Image size 2102x1736: 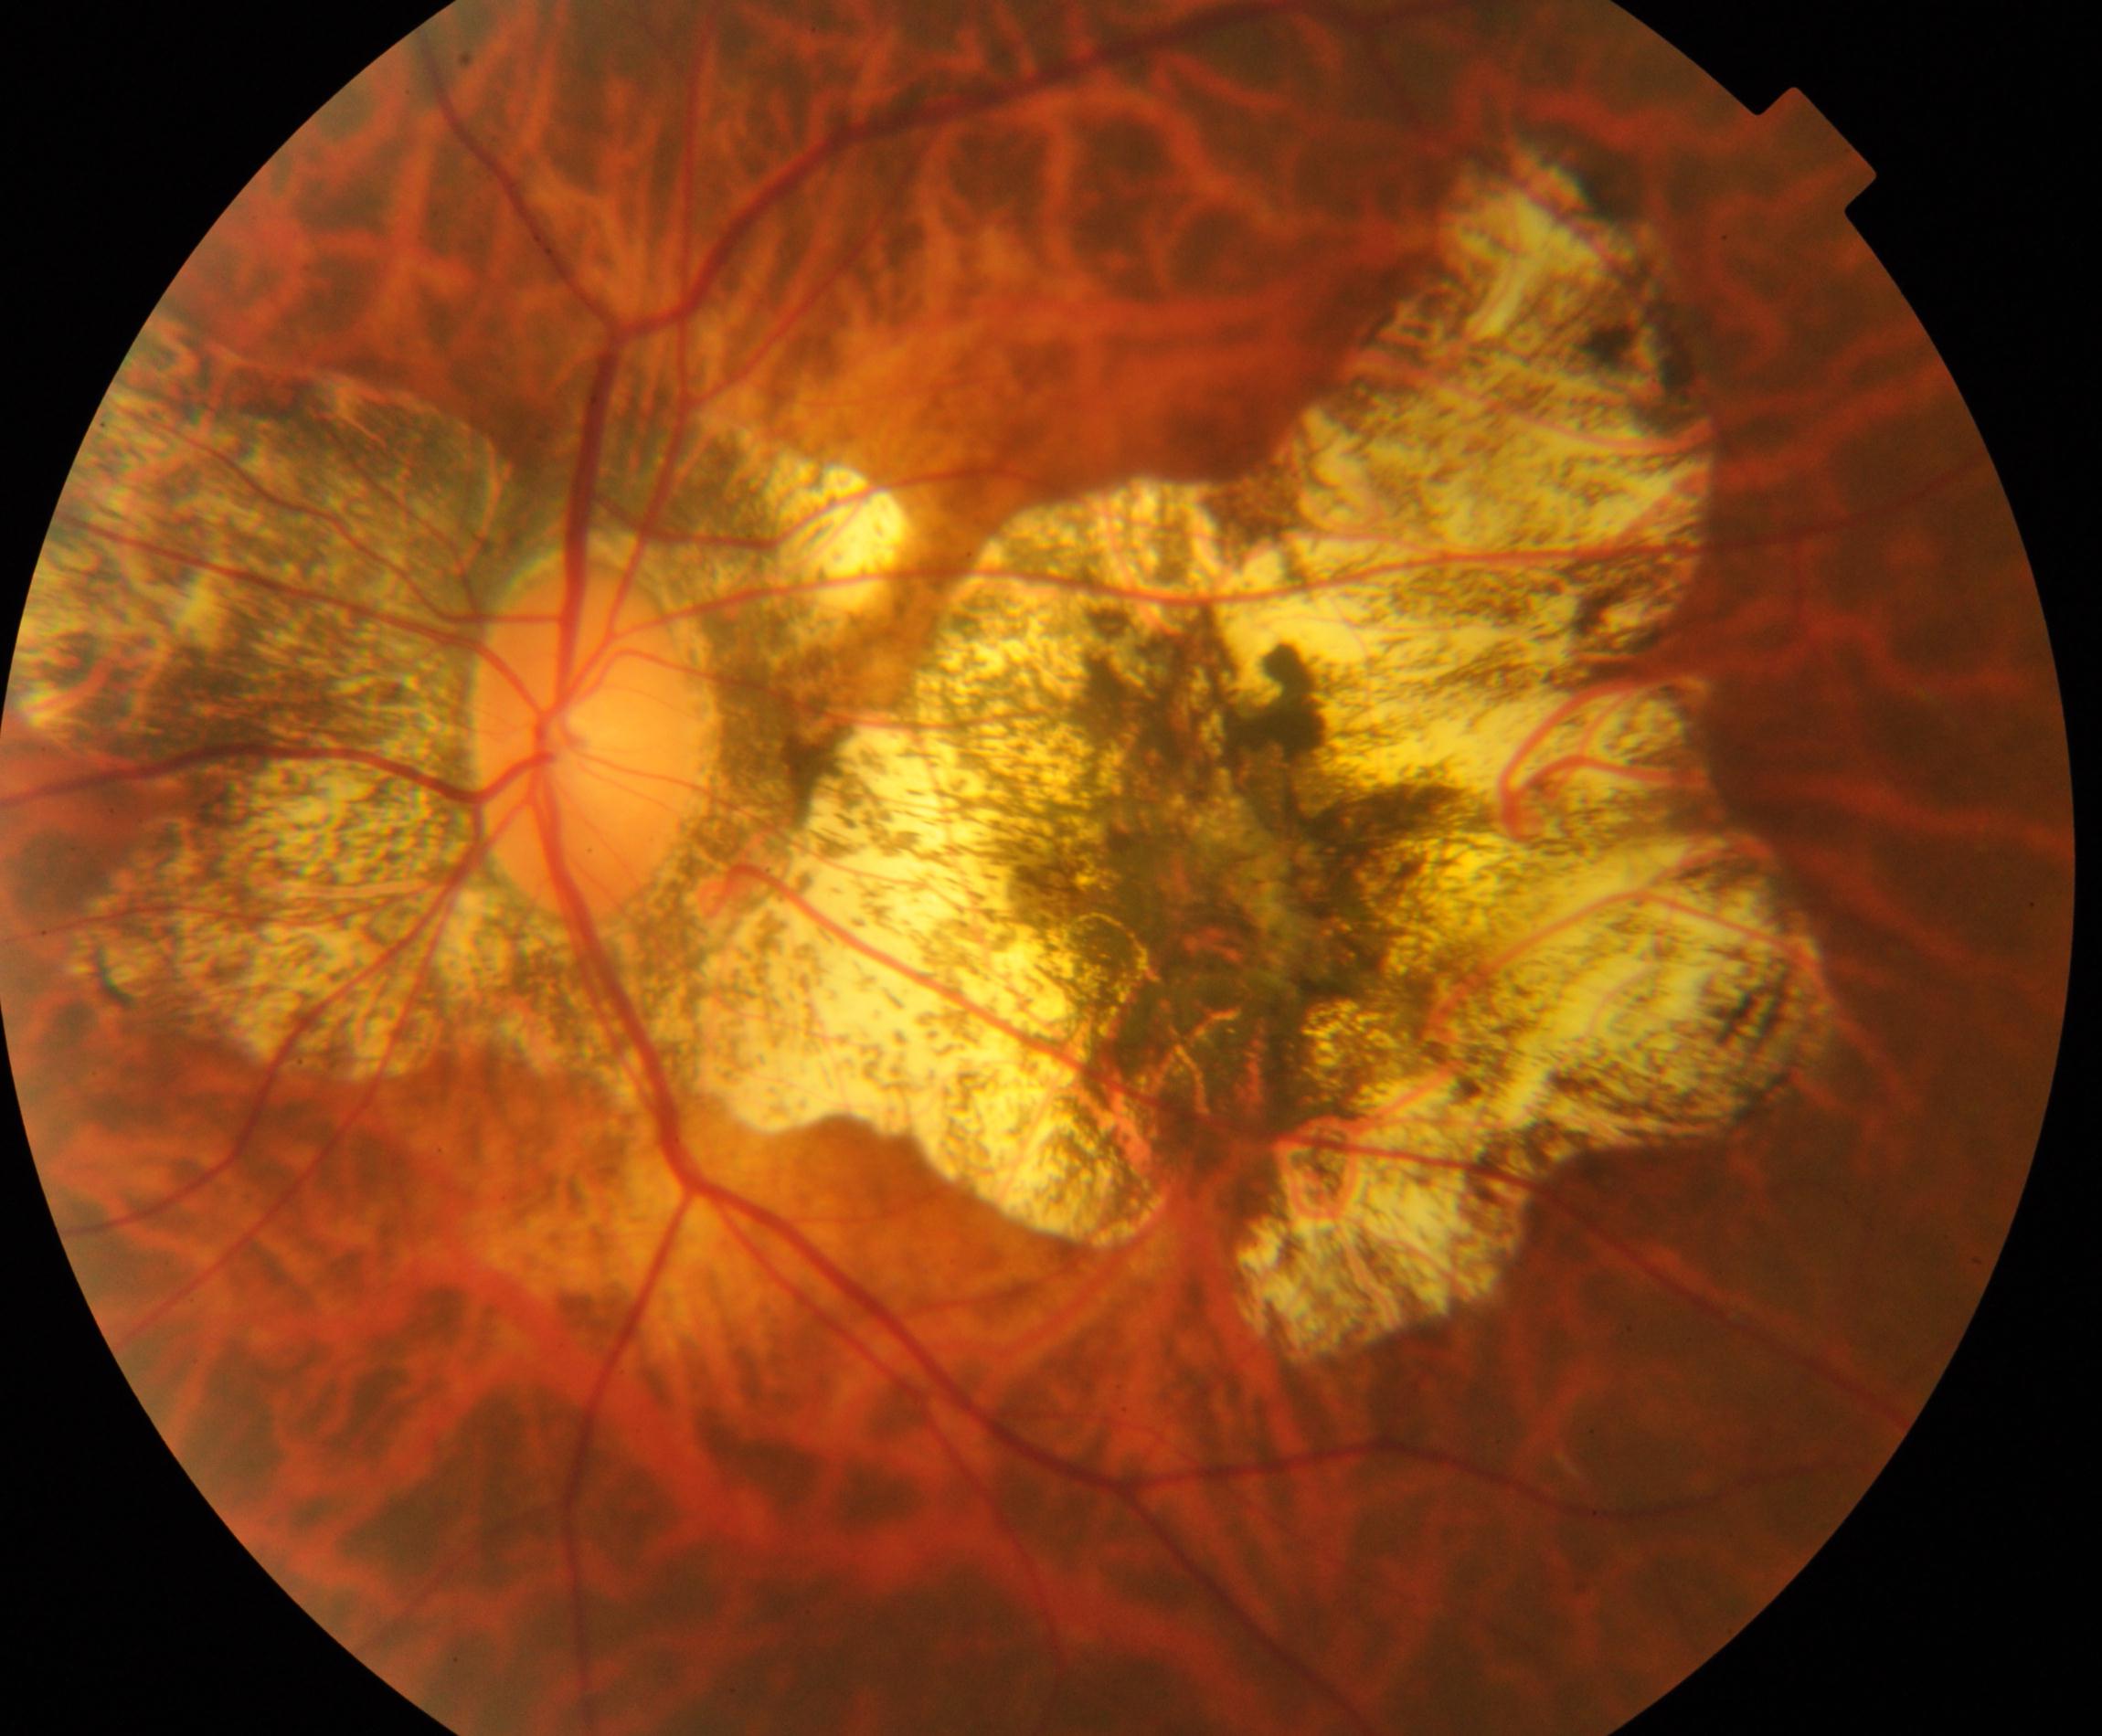

Findings: pathological myopia.